2048x1536 — 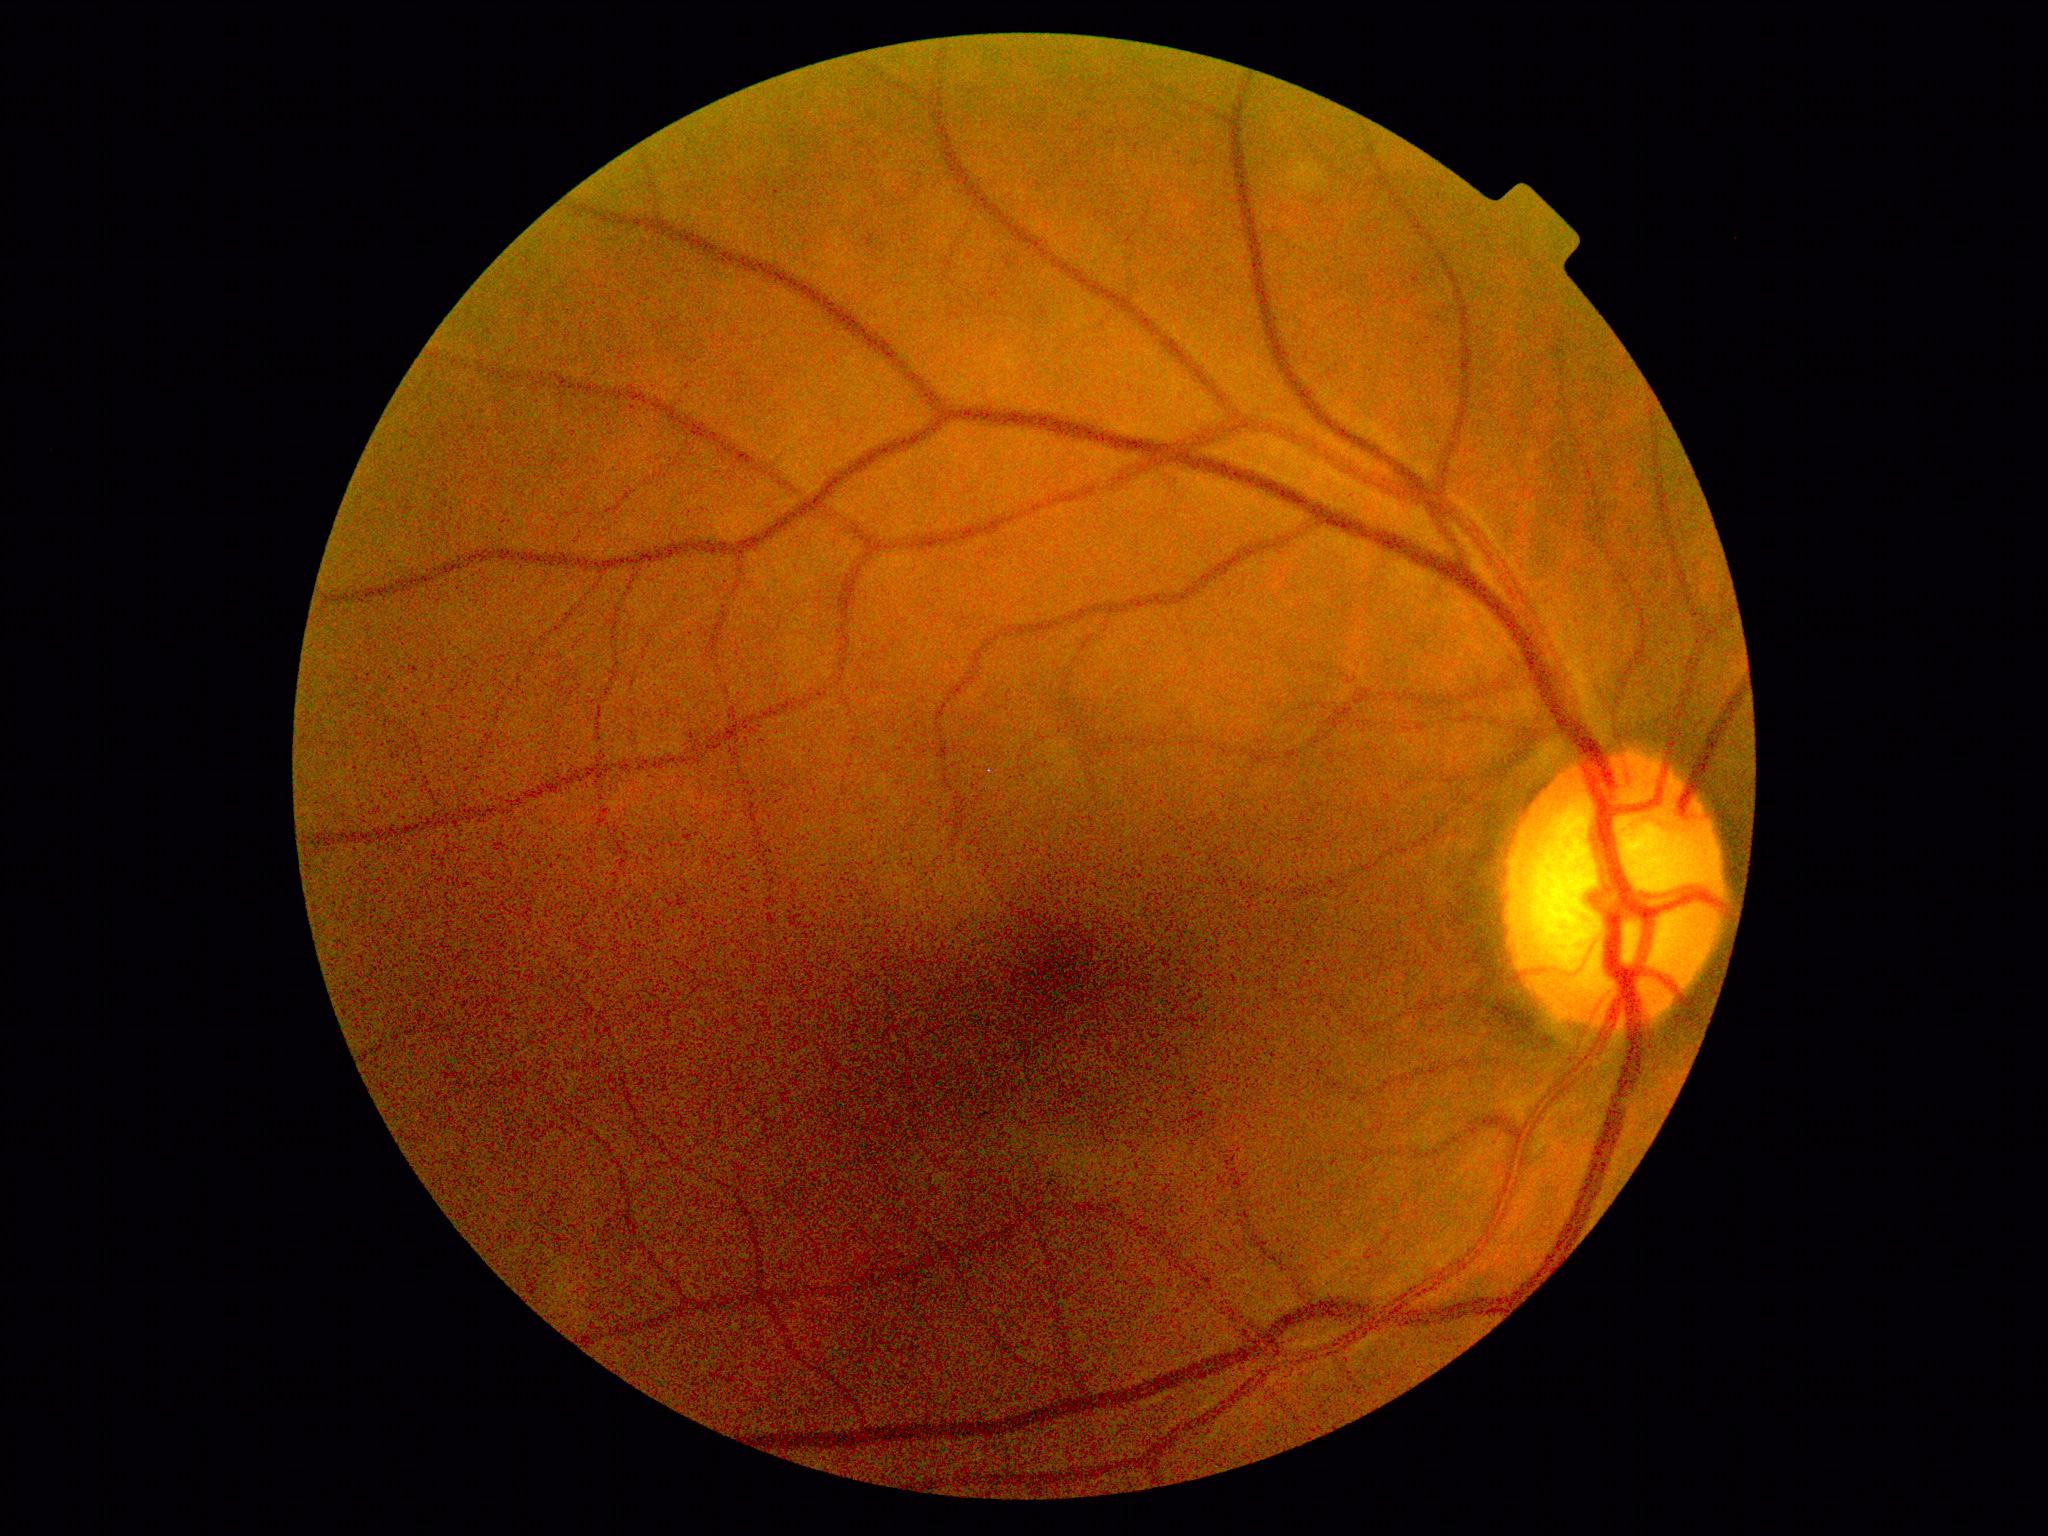 DR: 0/4.